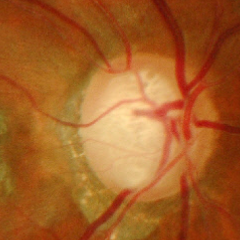 Showing advanced glaucoma.